Image size 2089x1764; CFP — 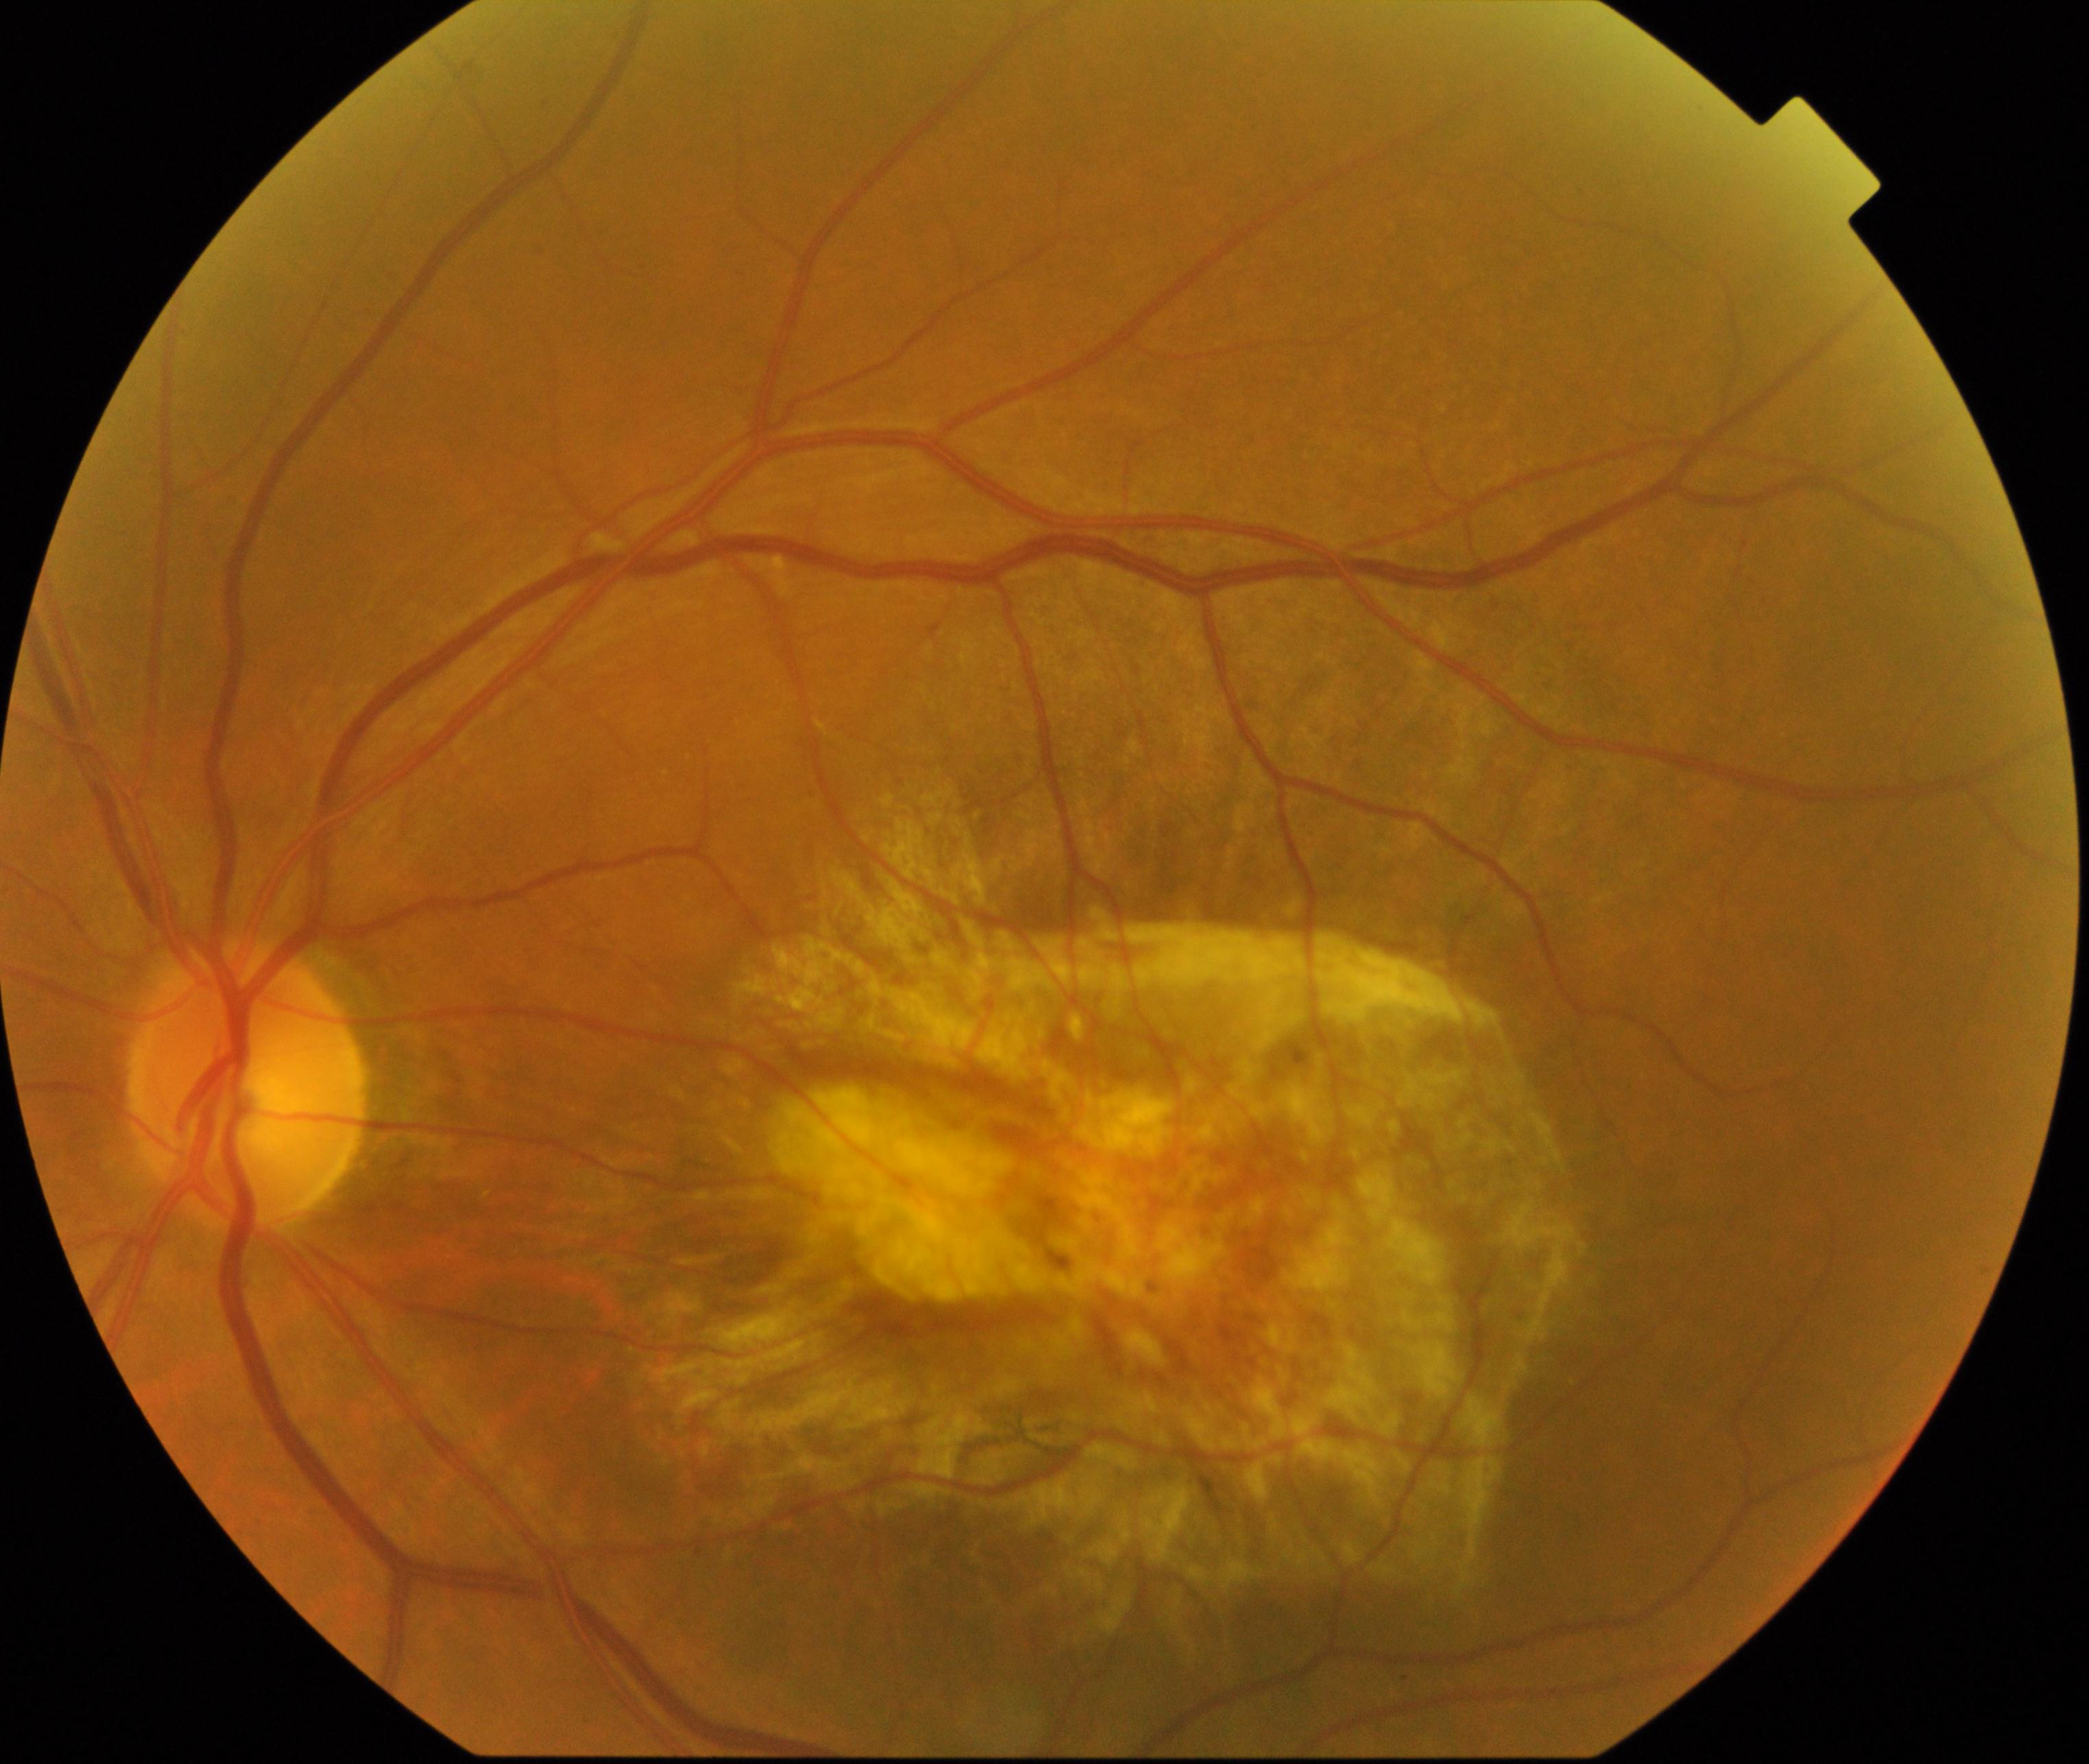 Demonstrates maculopathy.